45° field of view: 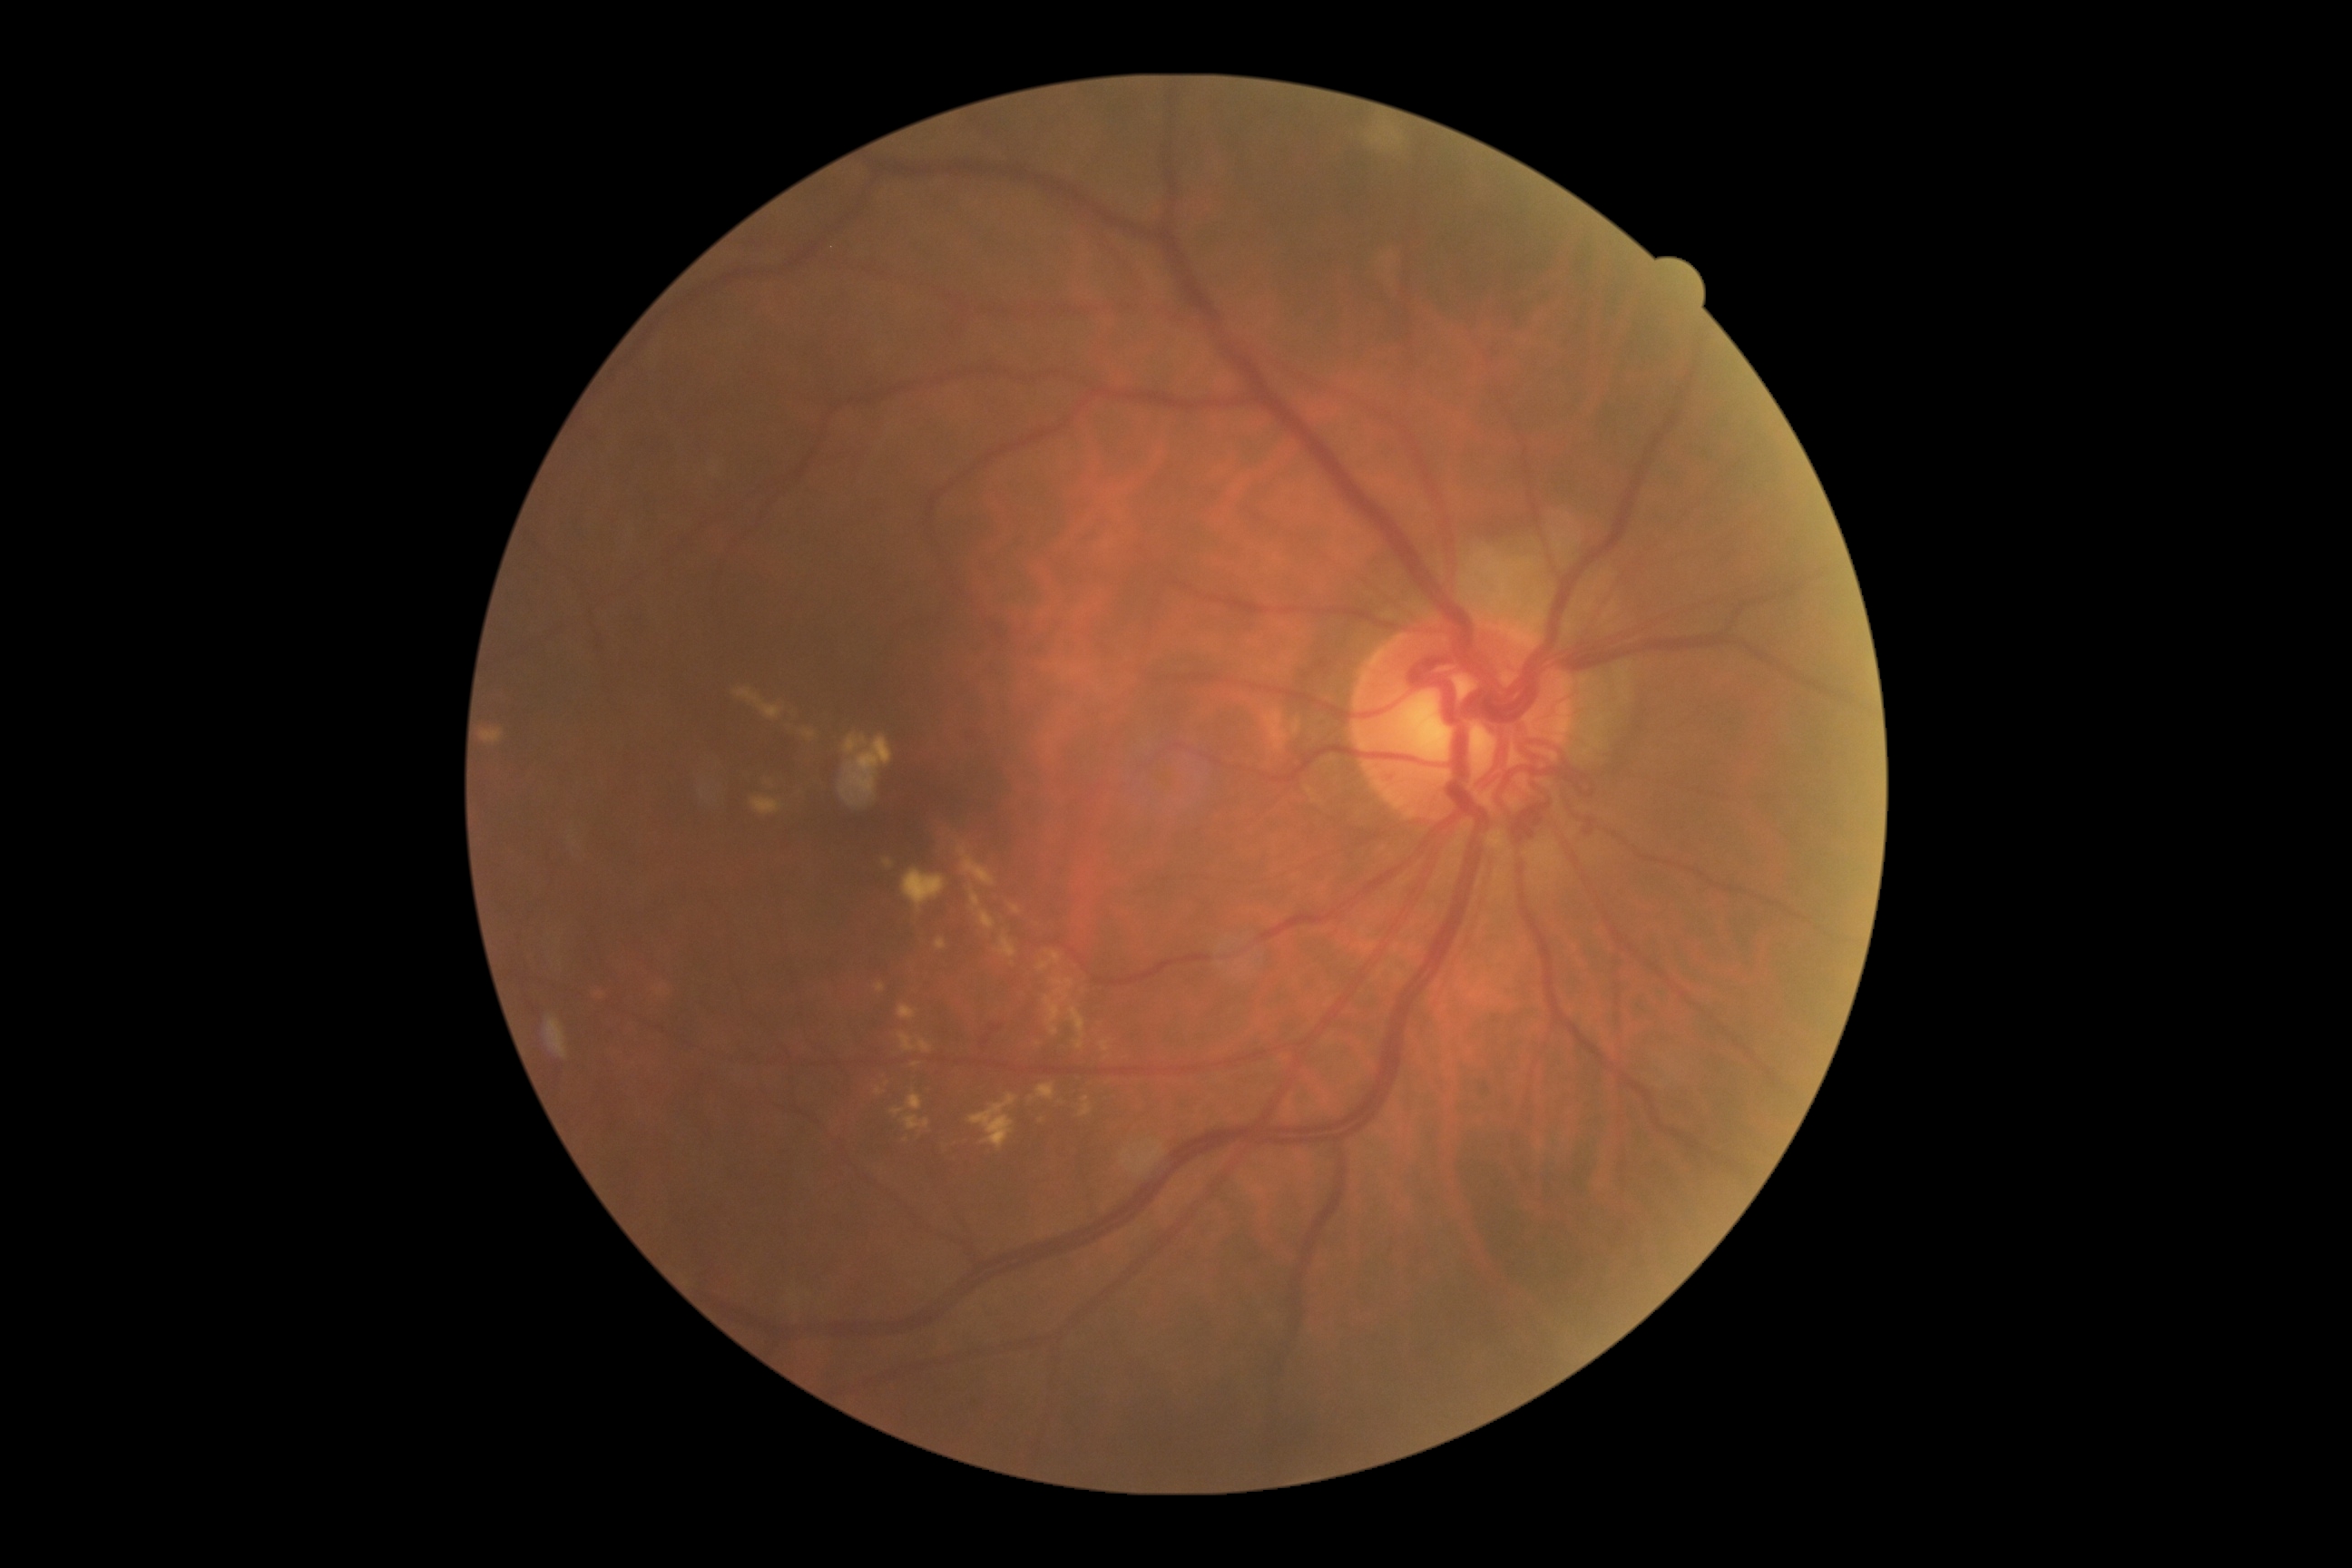

diabetic retinopathy (DR)=grade 2; DR class=non-proliferative diabetic retinopathy.